Nonmydriatic fundus photograph.
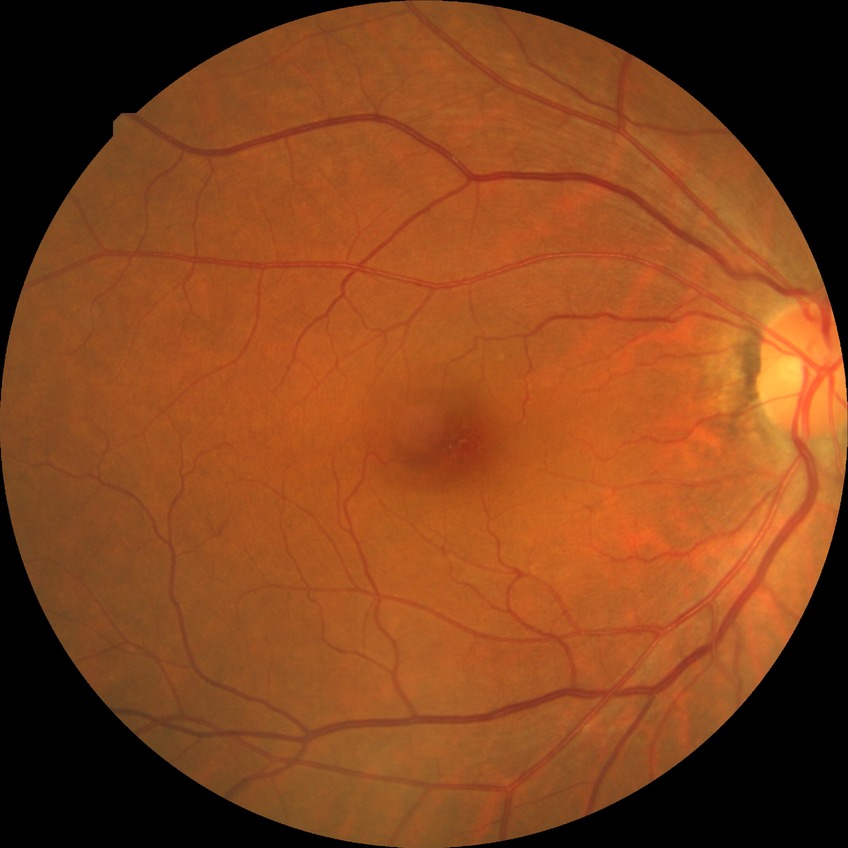
Diabetic retinopathy (DR): no diabetic retinopathy (NDR).